Nonmydriatic fundus photograph; posterior pole color fundus photograph — 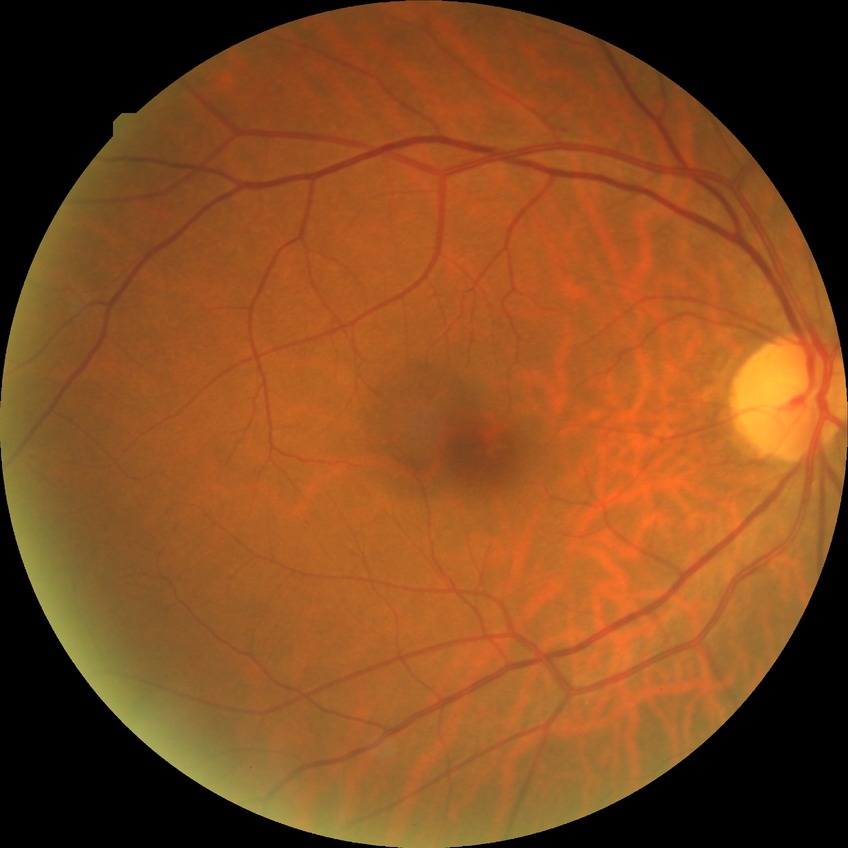

Diabetic retinopathy (DR): NDR (no diabetic retinopathy).